Captured with the Clarity RetCam 3 (130° field of view); wide-field contact fundus photograph of an infant.
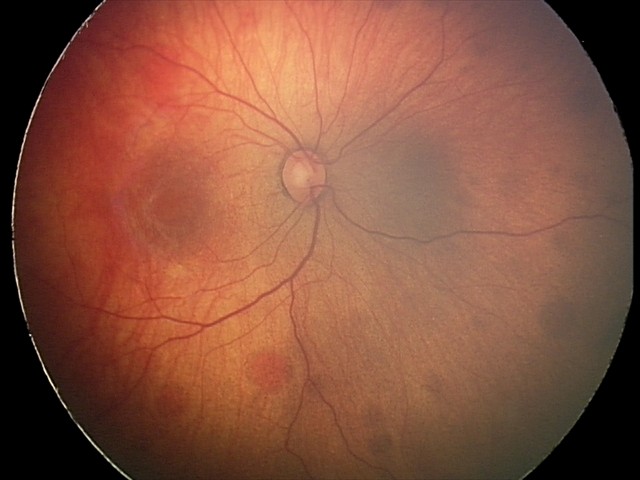 Screening examination consistent with retinal hemorrhages.